Pediatric retinal photograph (wide-field) · 1240x1240px.
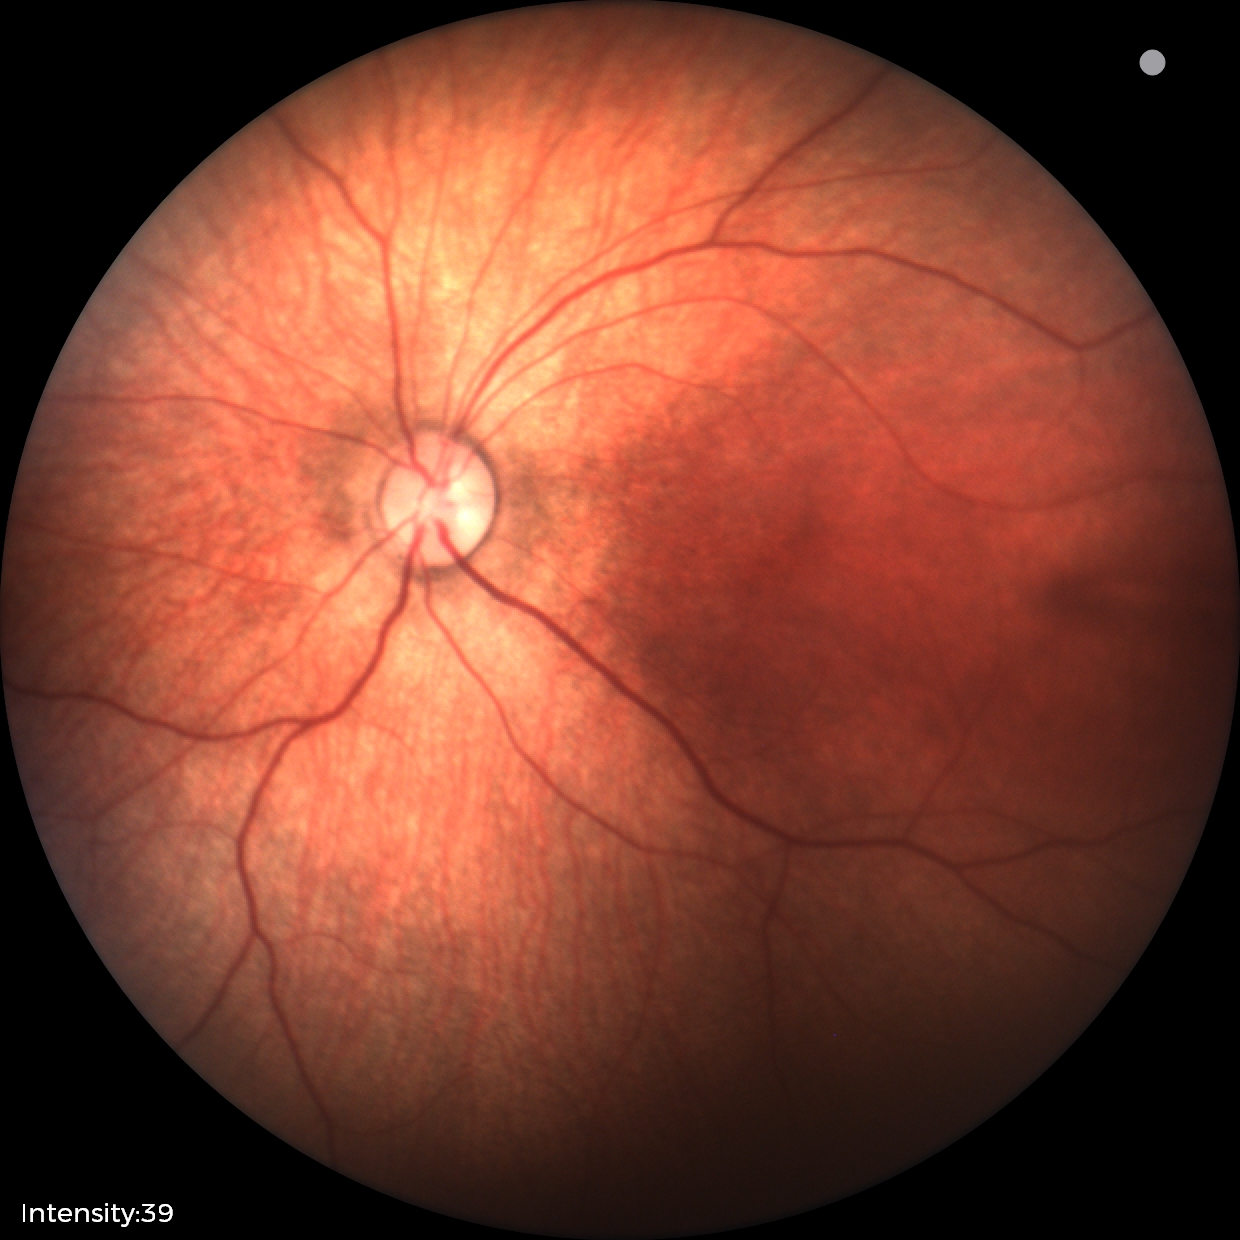

Screening diagnosis = normal retinal appearance.